Image size 2352x1568 · color fundus photograph · FOV: 45 degrees — 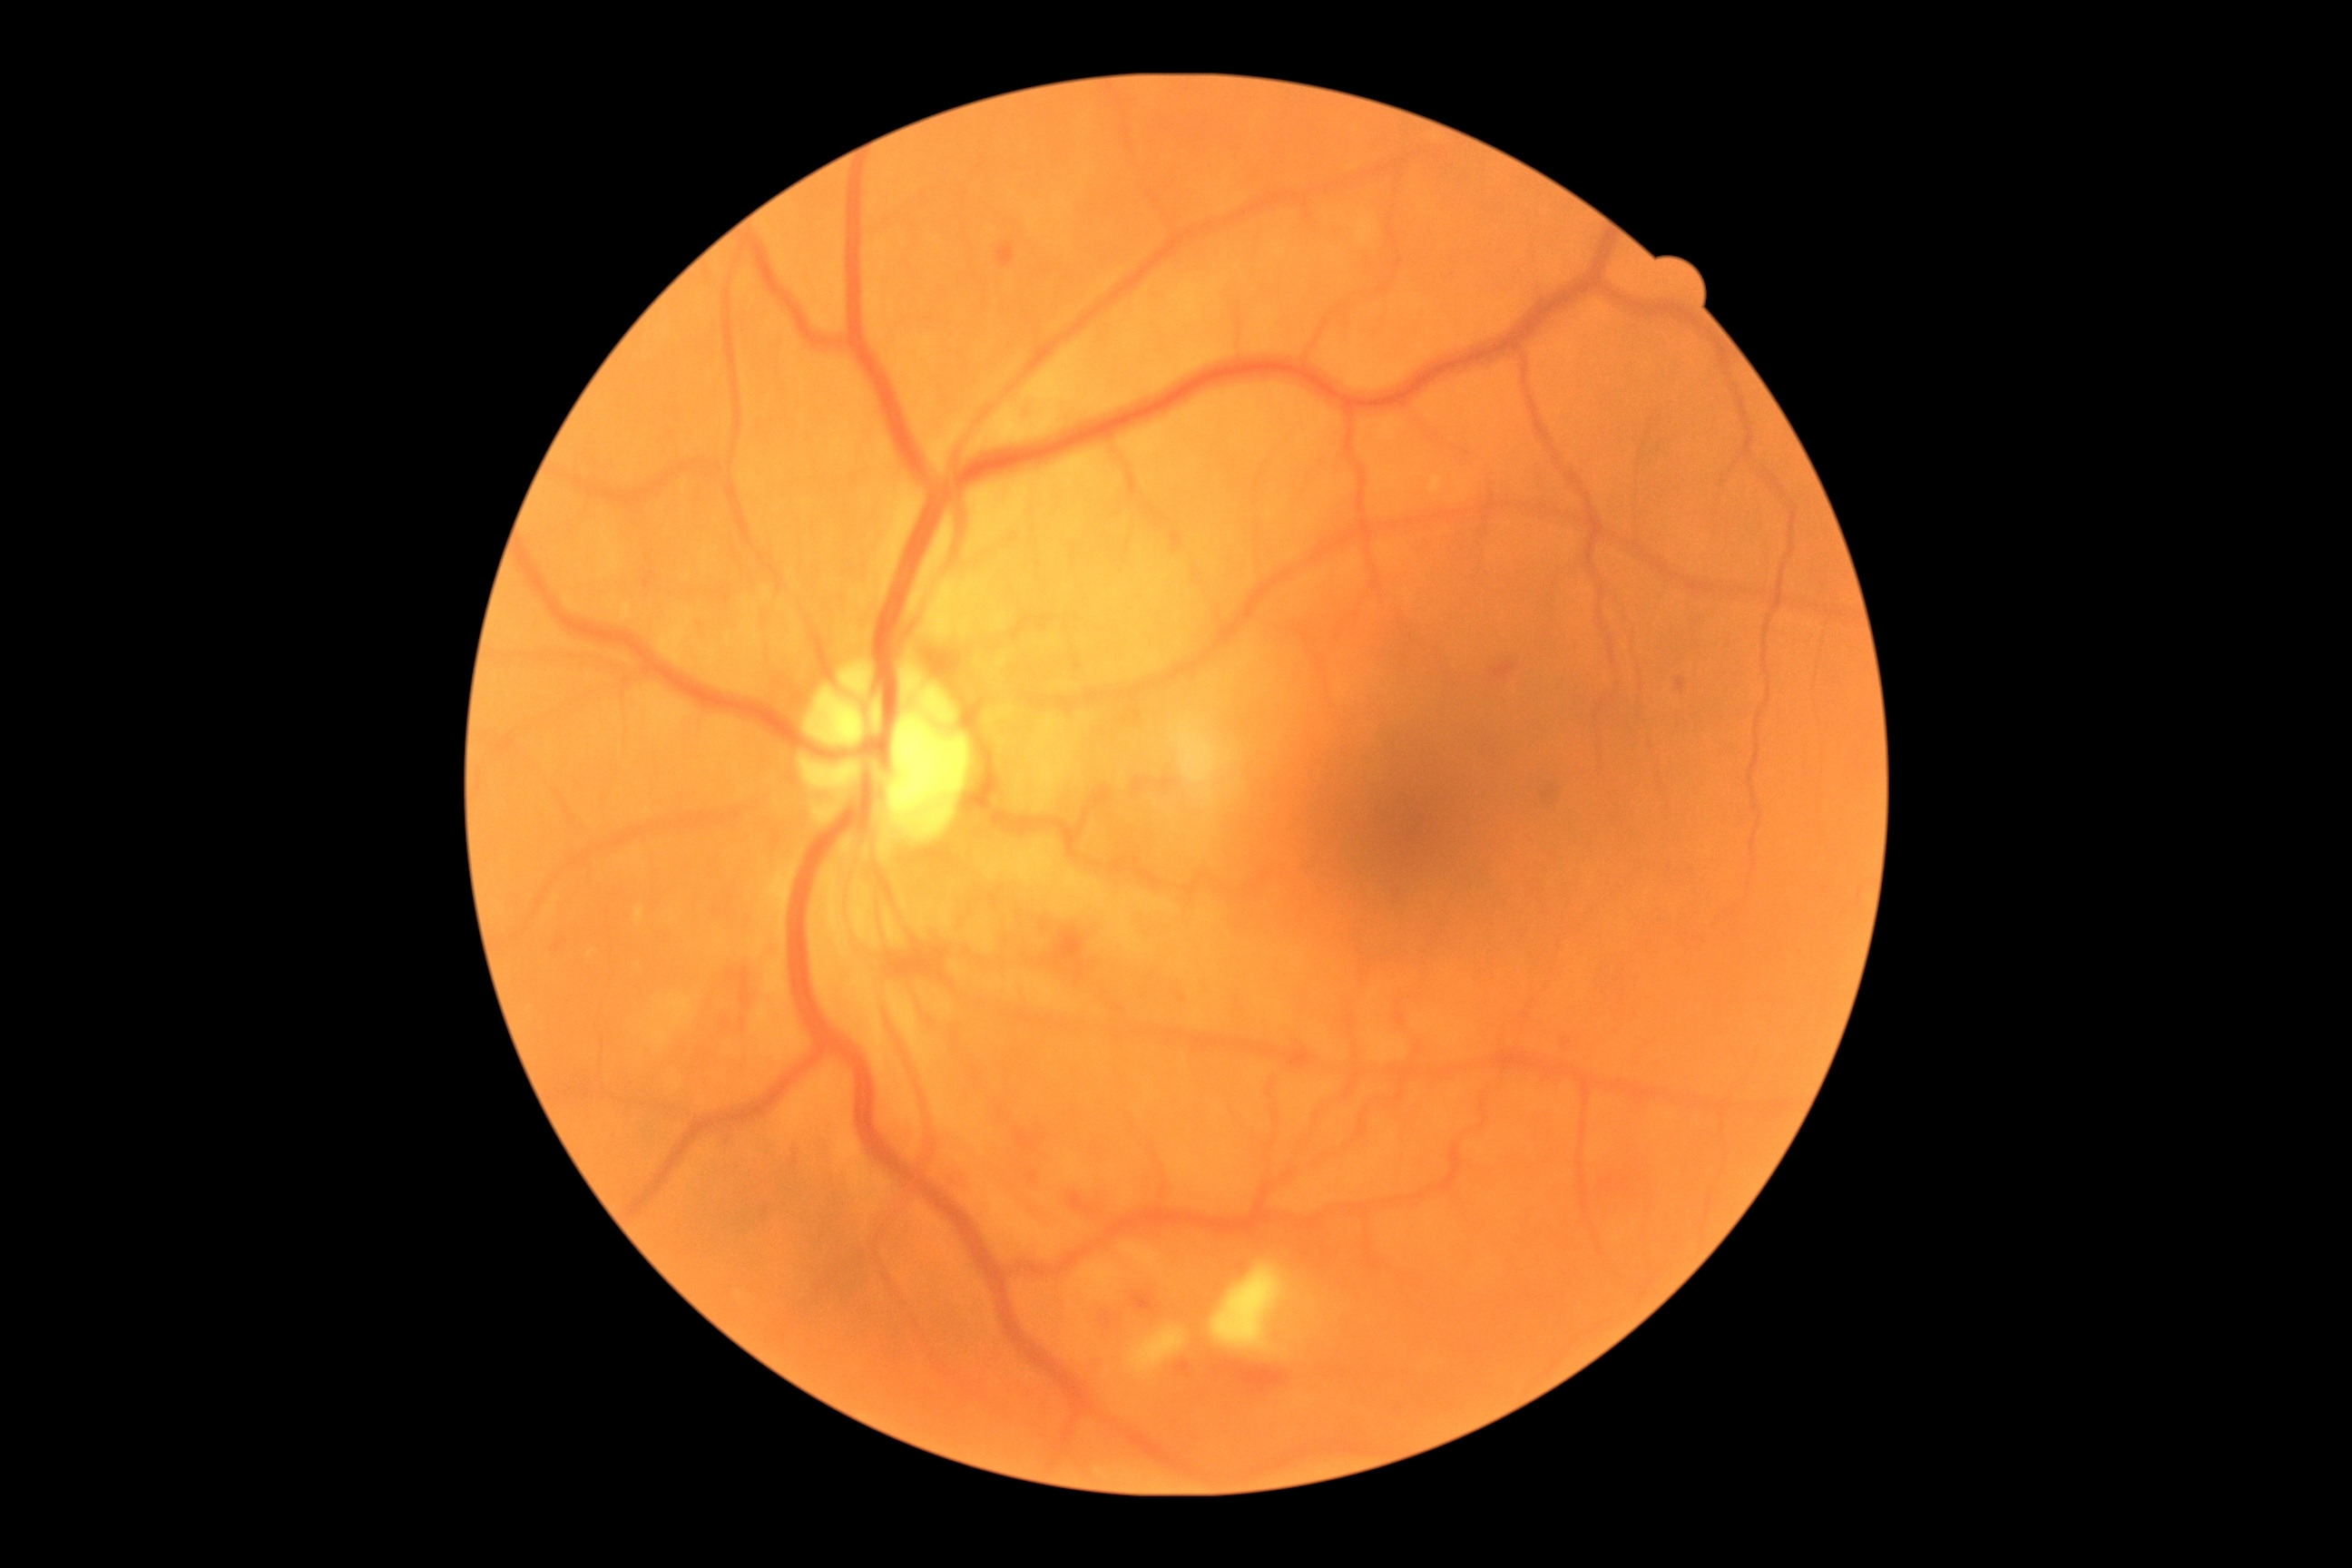

DR stage is 2/4.